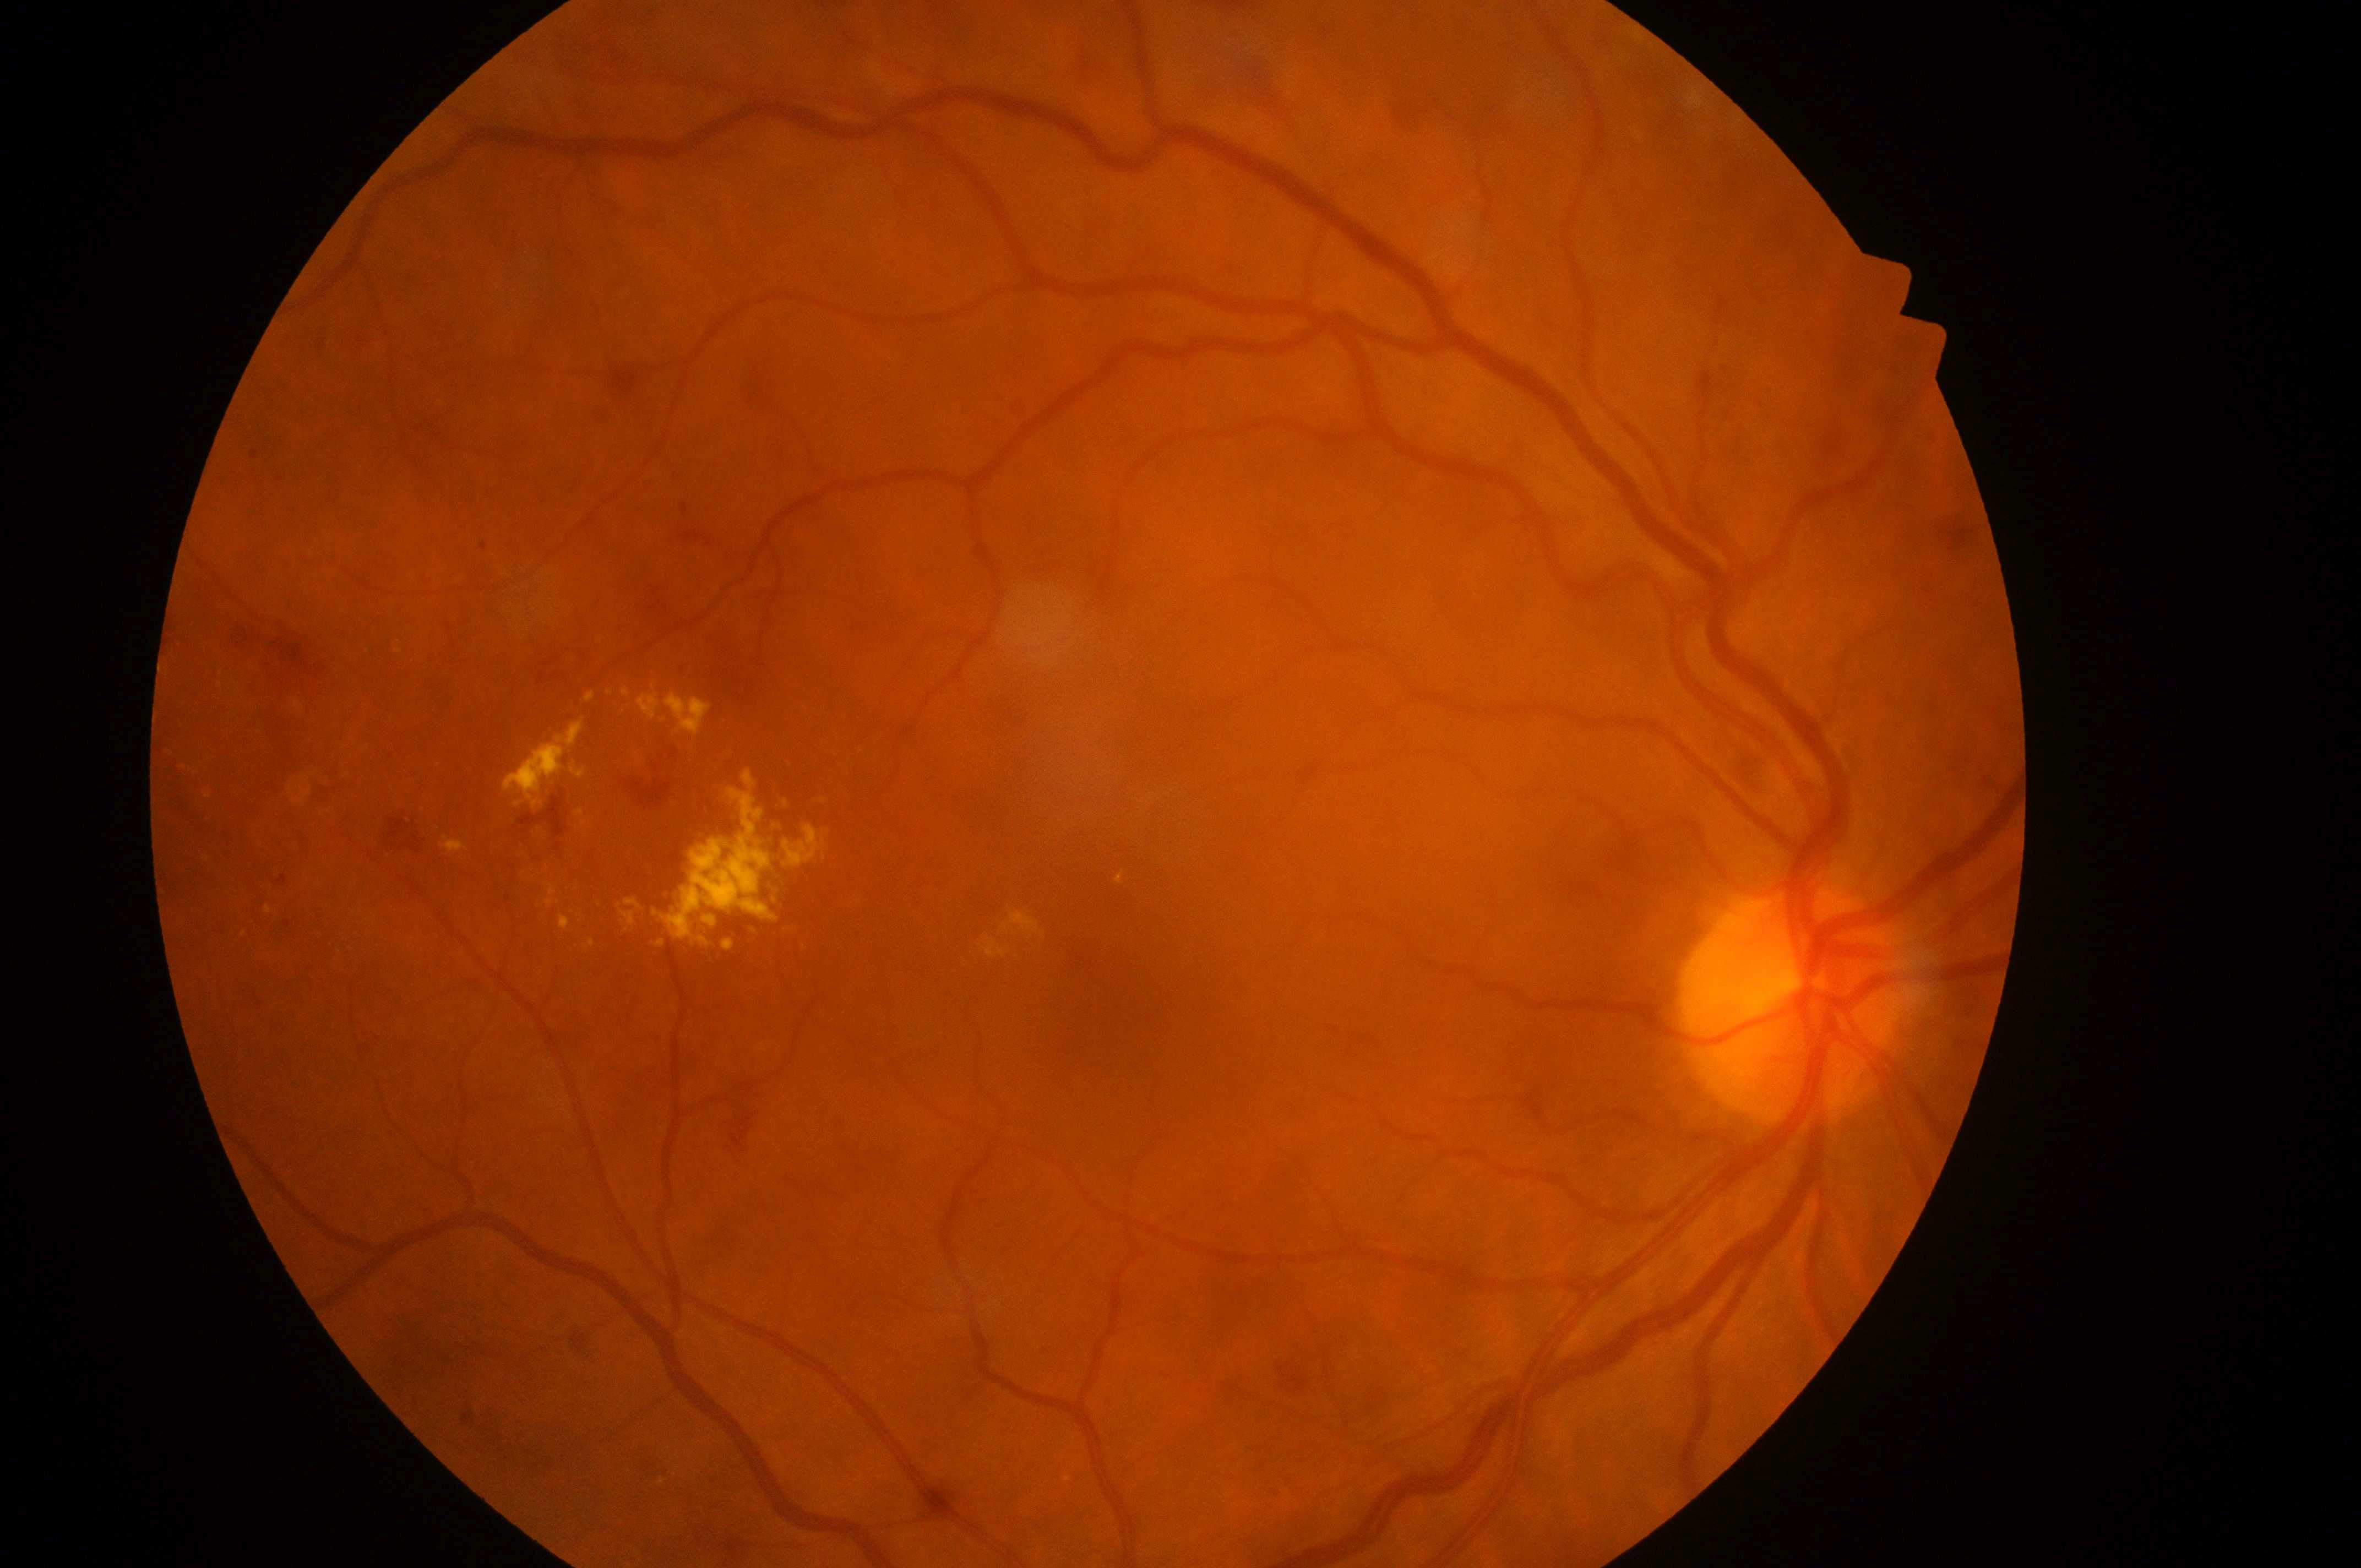

DR grade is moderate NPDR (2) — more than just microaneurysms but less than severe NPDR.
DME: high risk (grade 2) — hard exudates within one disc diameter of the macula center.
Fovea center: (x: 1101, y: 1021).
This is the right eye.
The optic nerve head is at (x: 1791, y: 1014).